Wide-field fundus photograph of an infant:
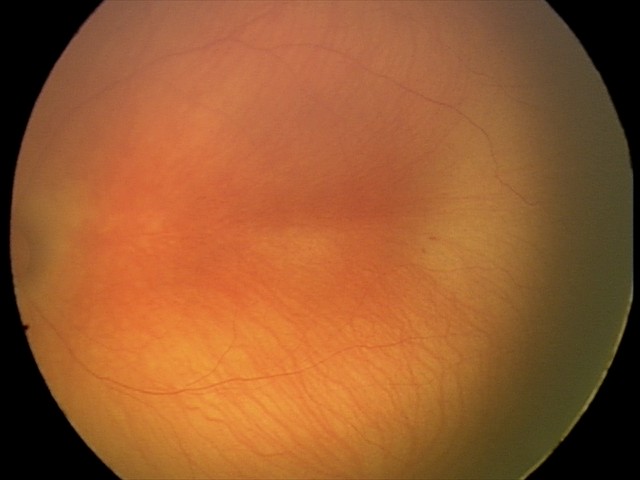 Screening examination diagnosed as physiological.